Retinal fundus photograph
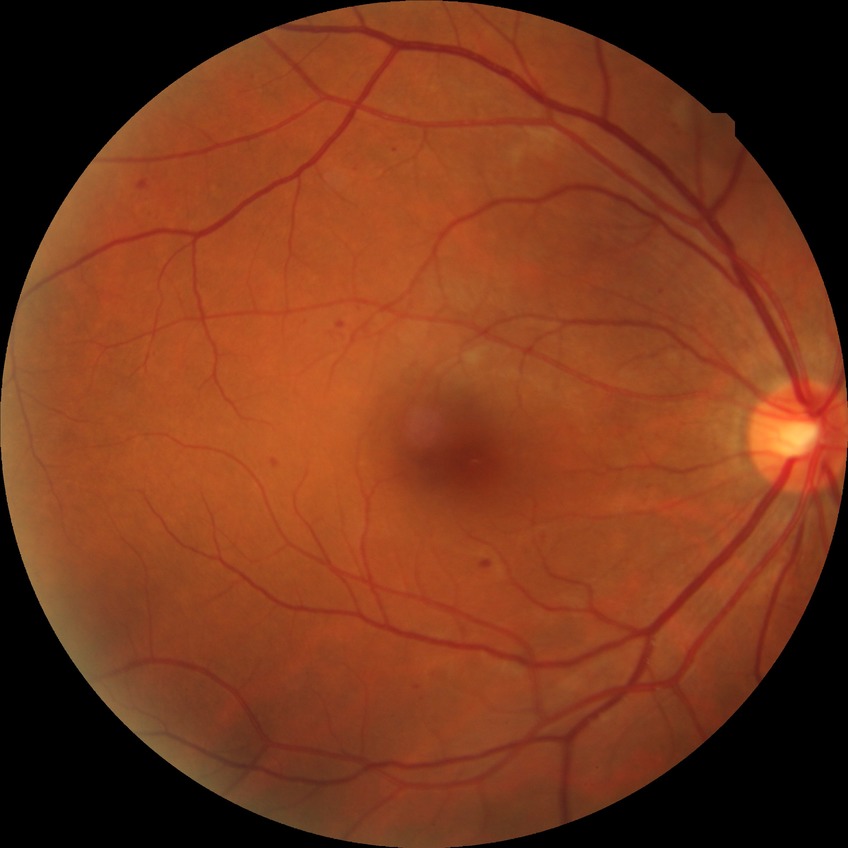
Retinopathy grade is pre-proliferative diabetic retinopathy.